Fundus photo: 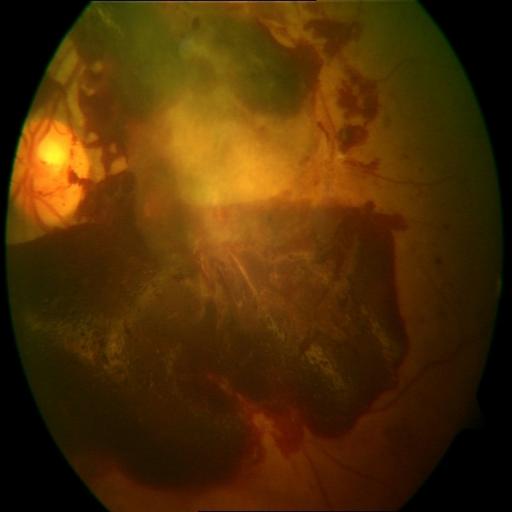 The image shows preretinal hemorrhage (PRH).